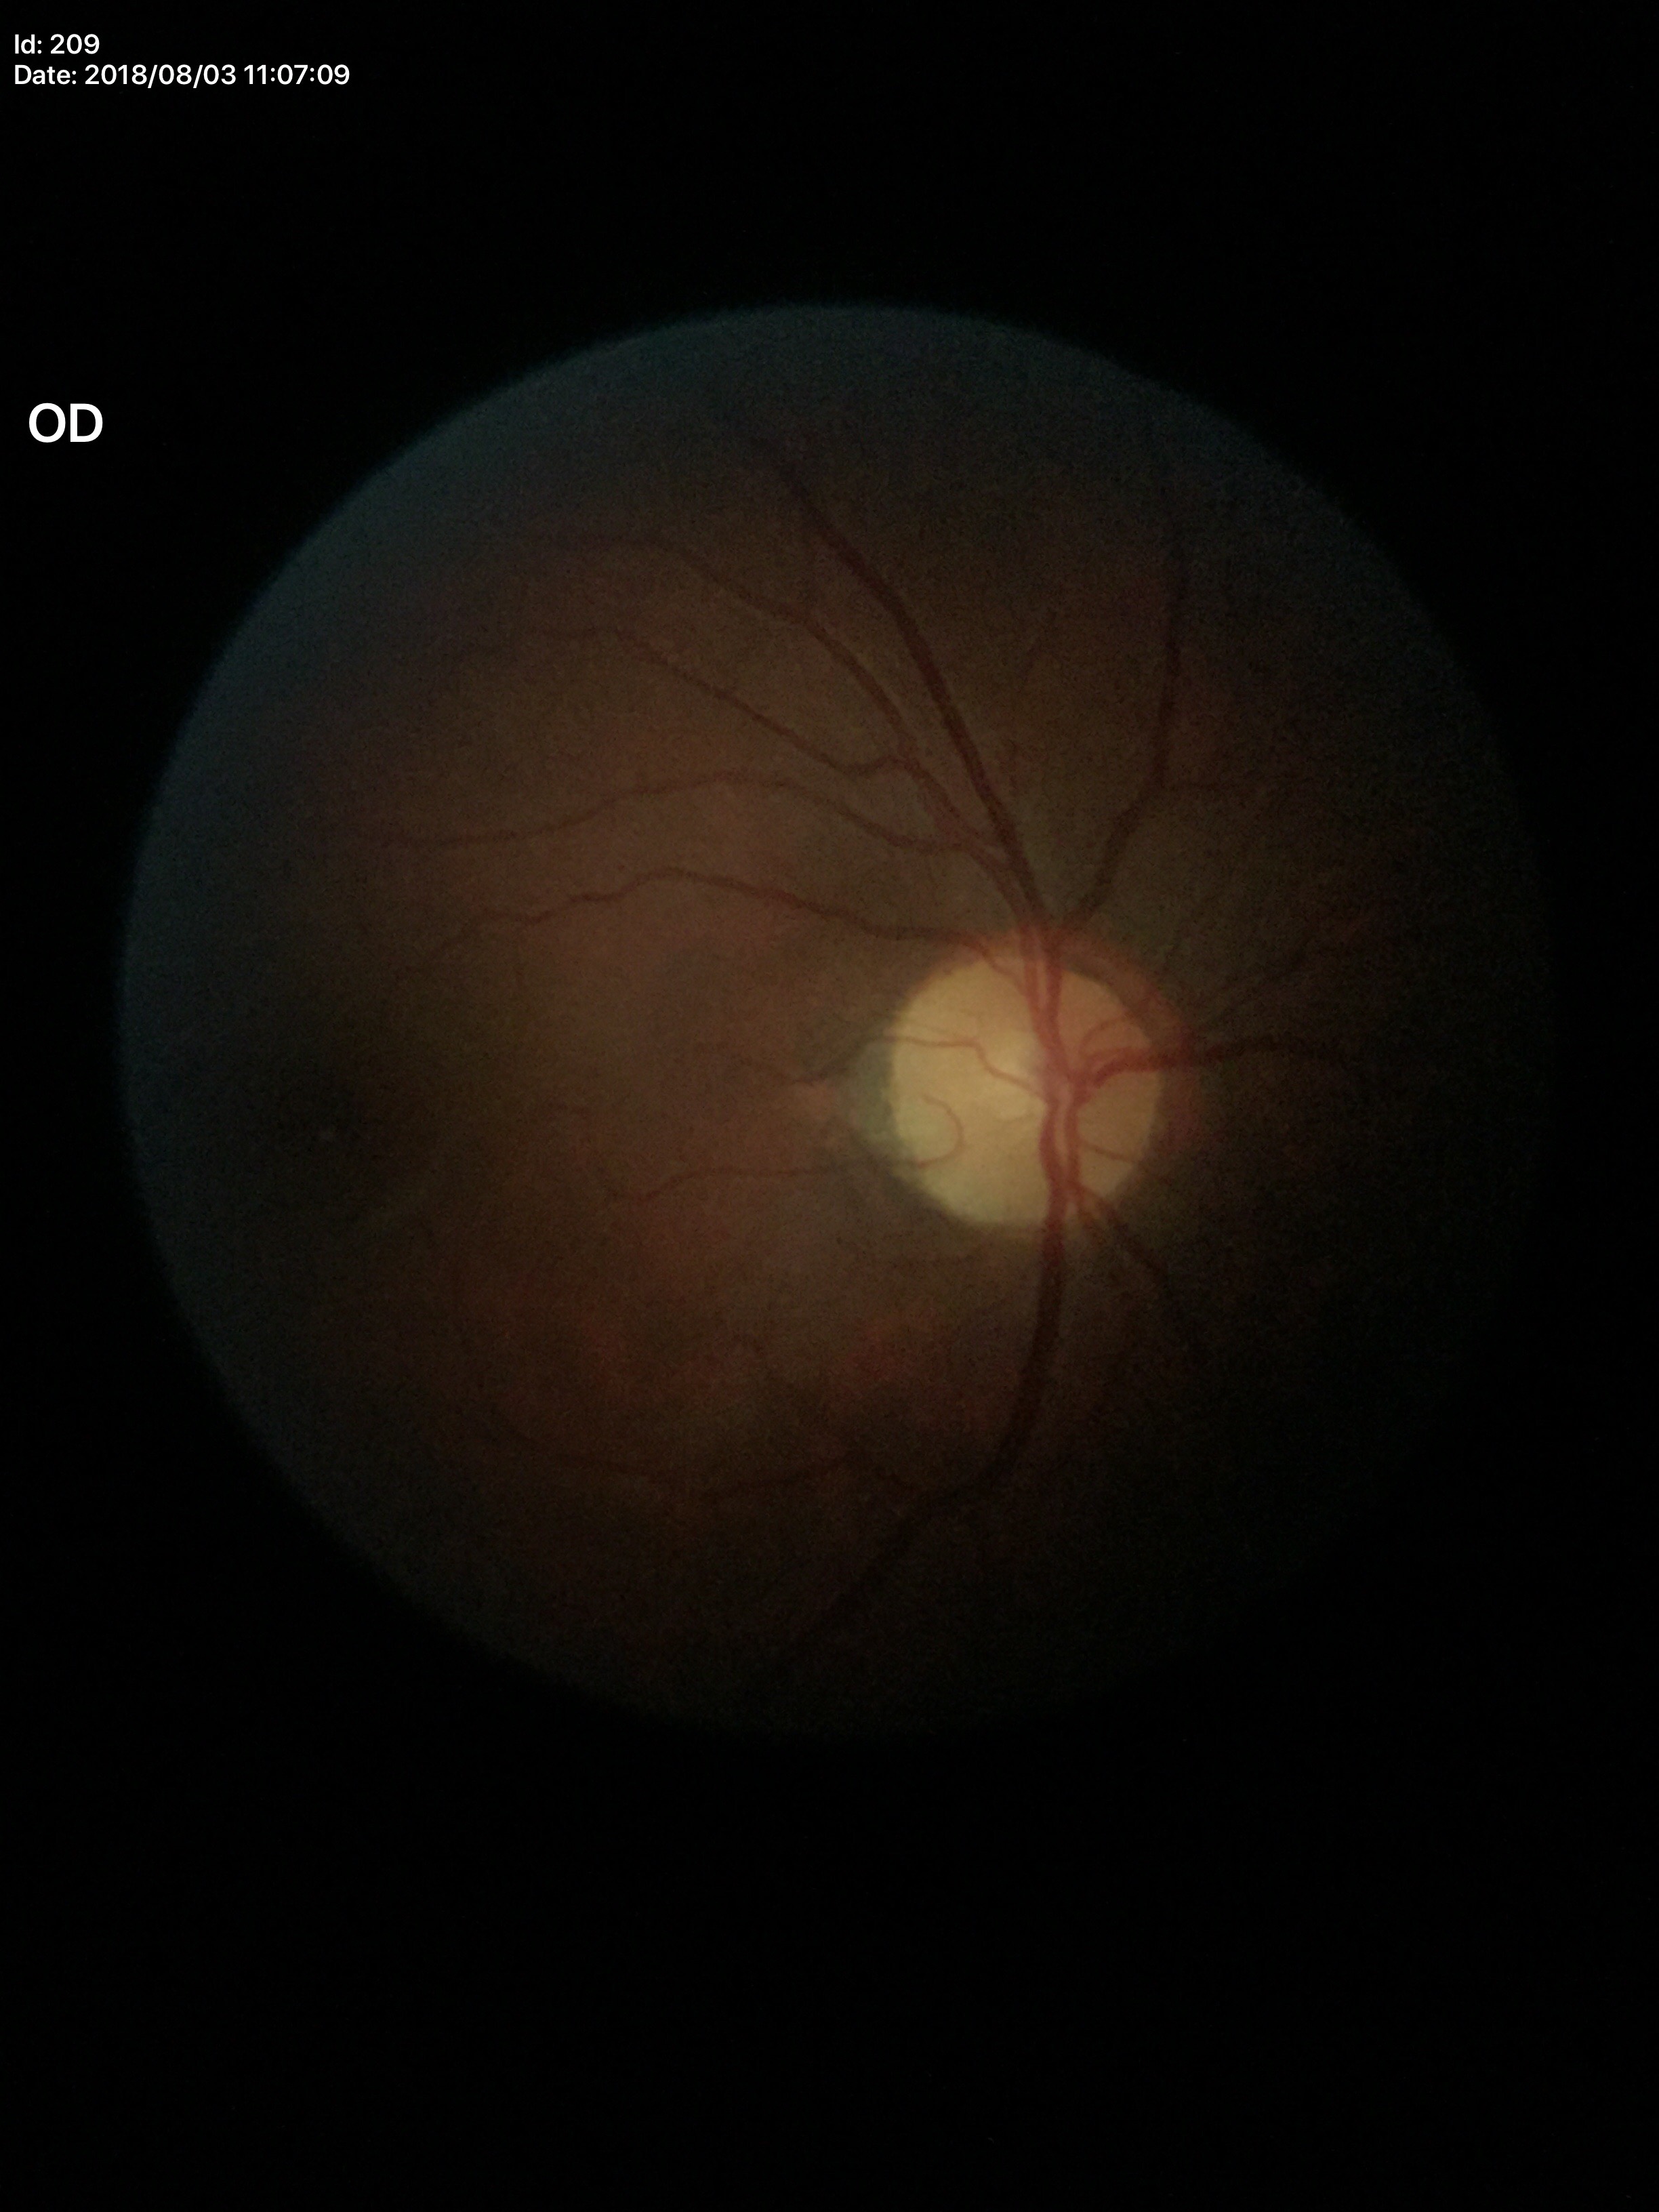
Vertical cup-to-disc ratio (VCDR) is 0.42. Glaucoma evaluation: negative (all 5 graders called normal).